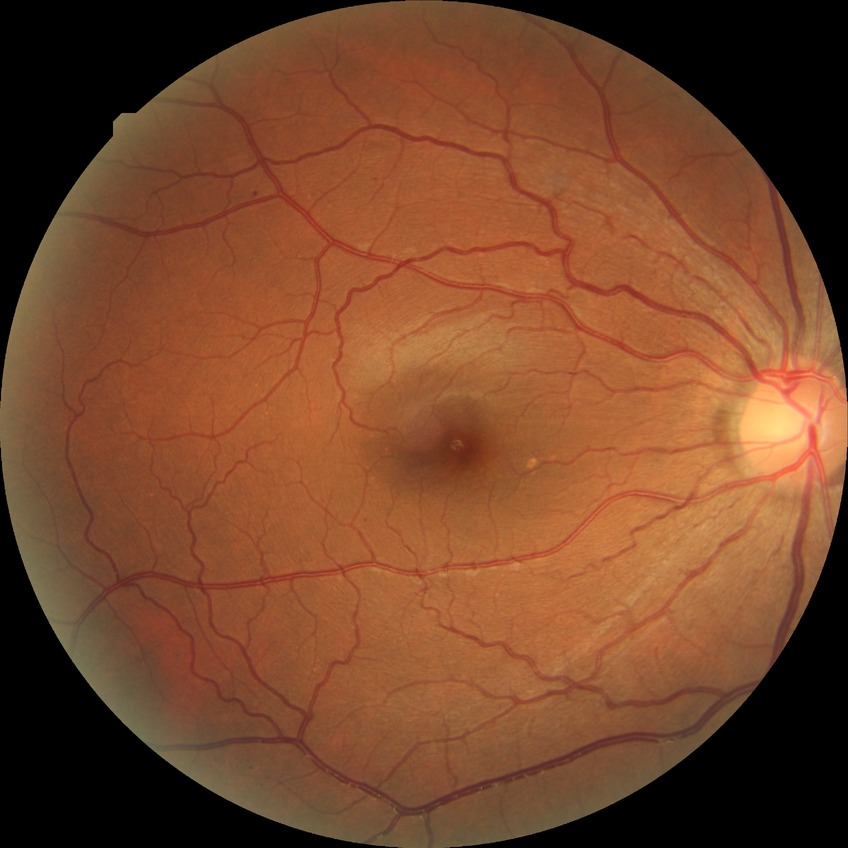
Retinopathy stage: simple diabetic retinopathy.